Image size 1725x1721 · fundus photo · FOV: 45 degrees
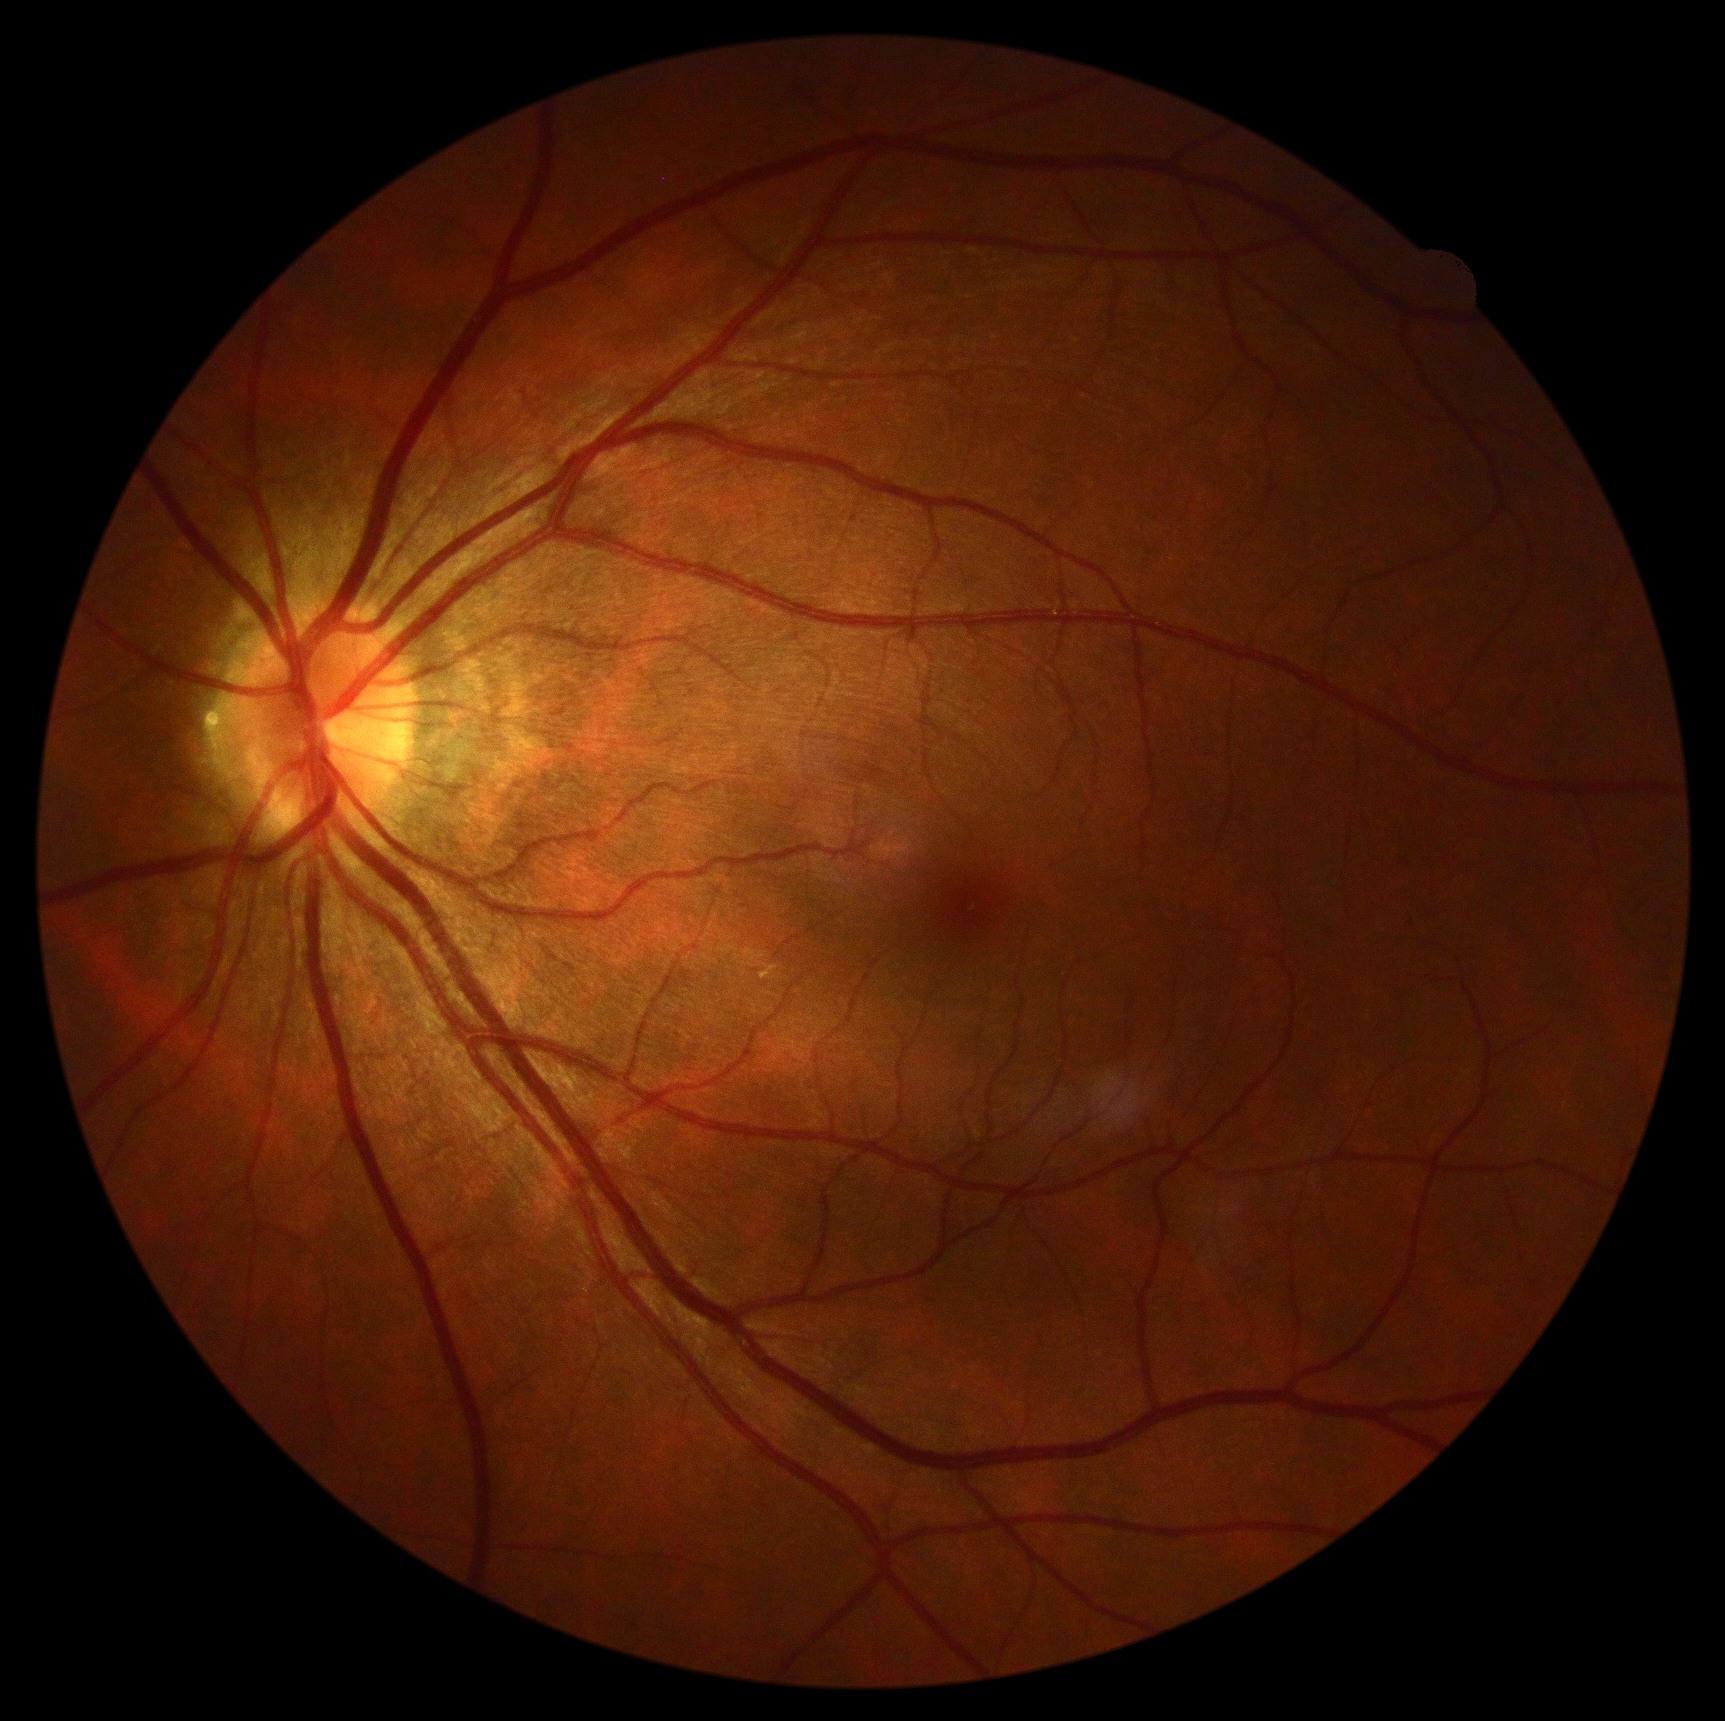

DR grade is 0/4.